Color fundus photograph from a handheld portable camera. 2212 by 1659 pixels: 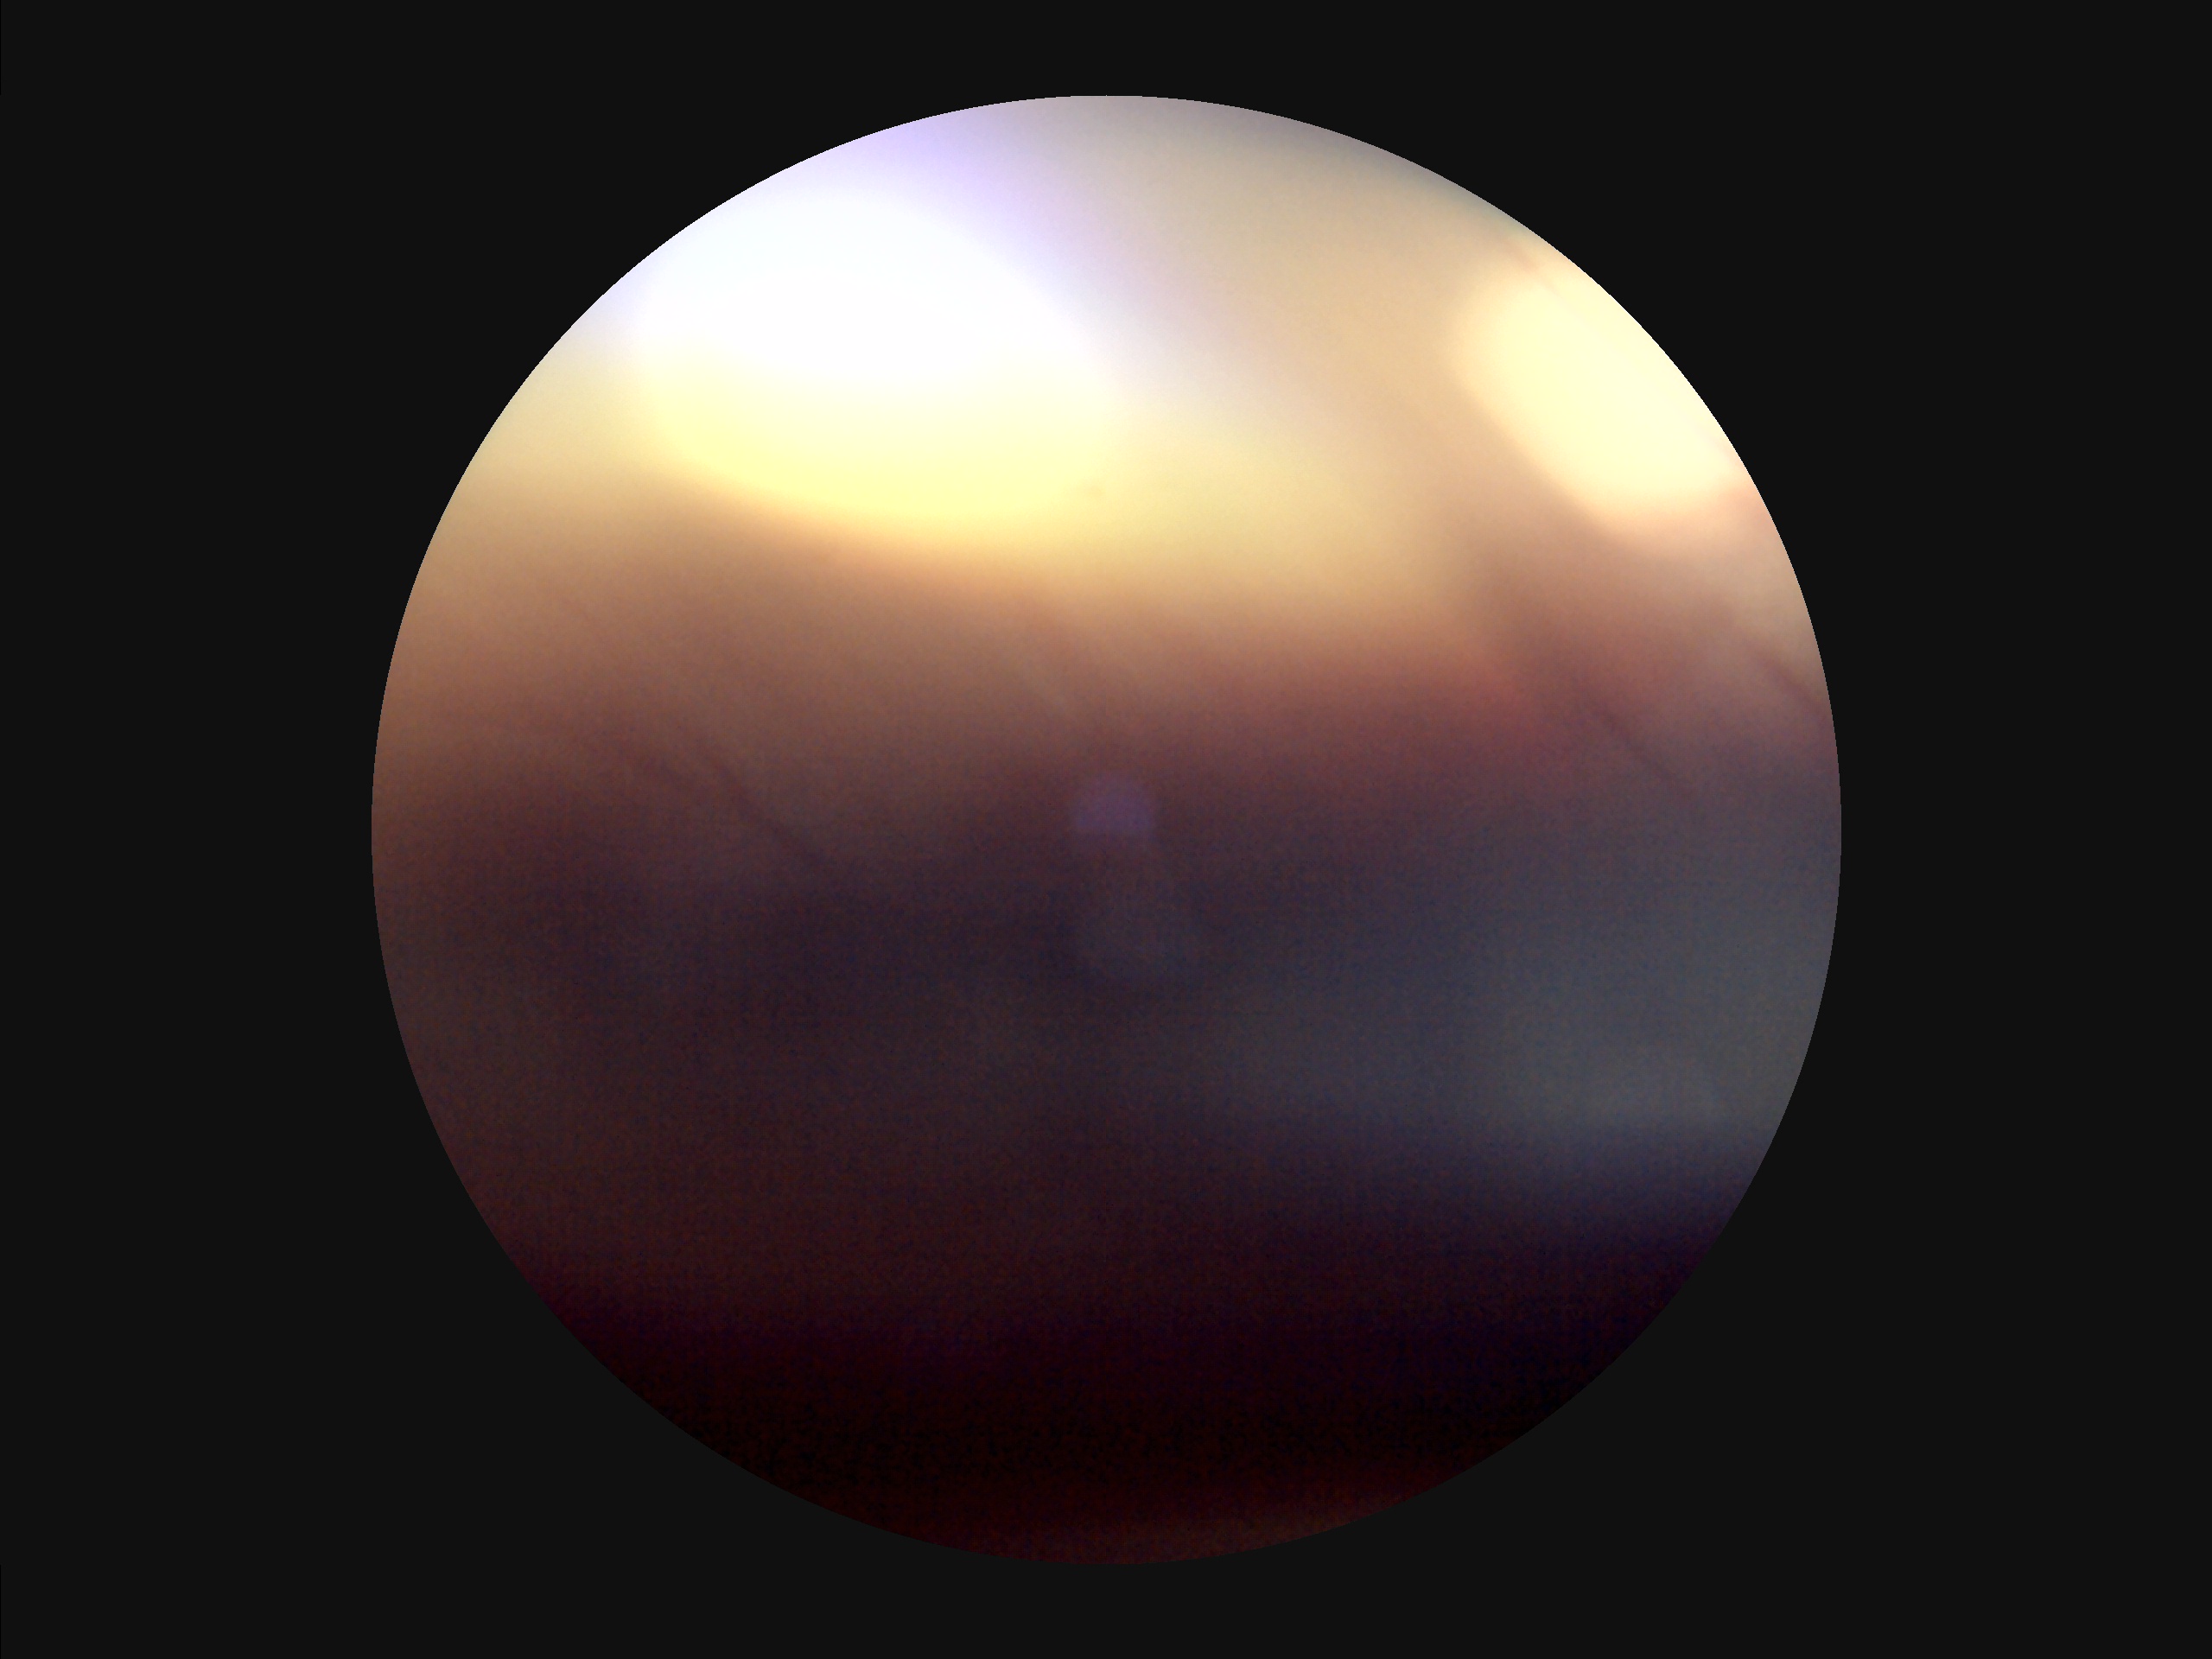
Illumination = inadequate, with uneven exposure or color distortion; Focus = noticeable blur in the optic disc, vessels, or background; Overall image quality = poor, ungradable; Contrast = poor dynamic range.